50° field of view, field includes the optic disc and macula:
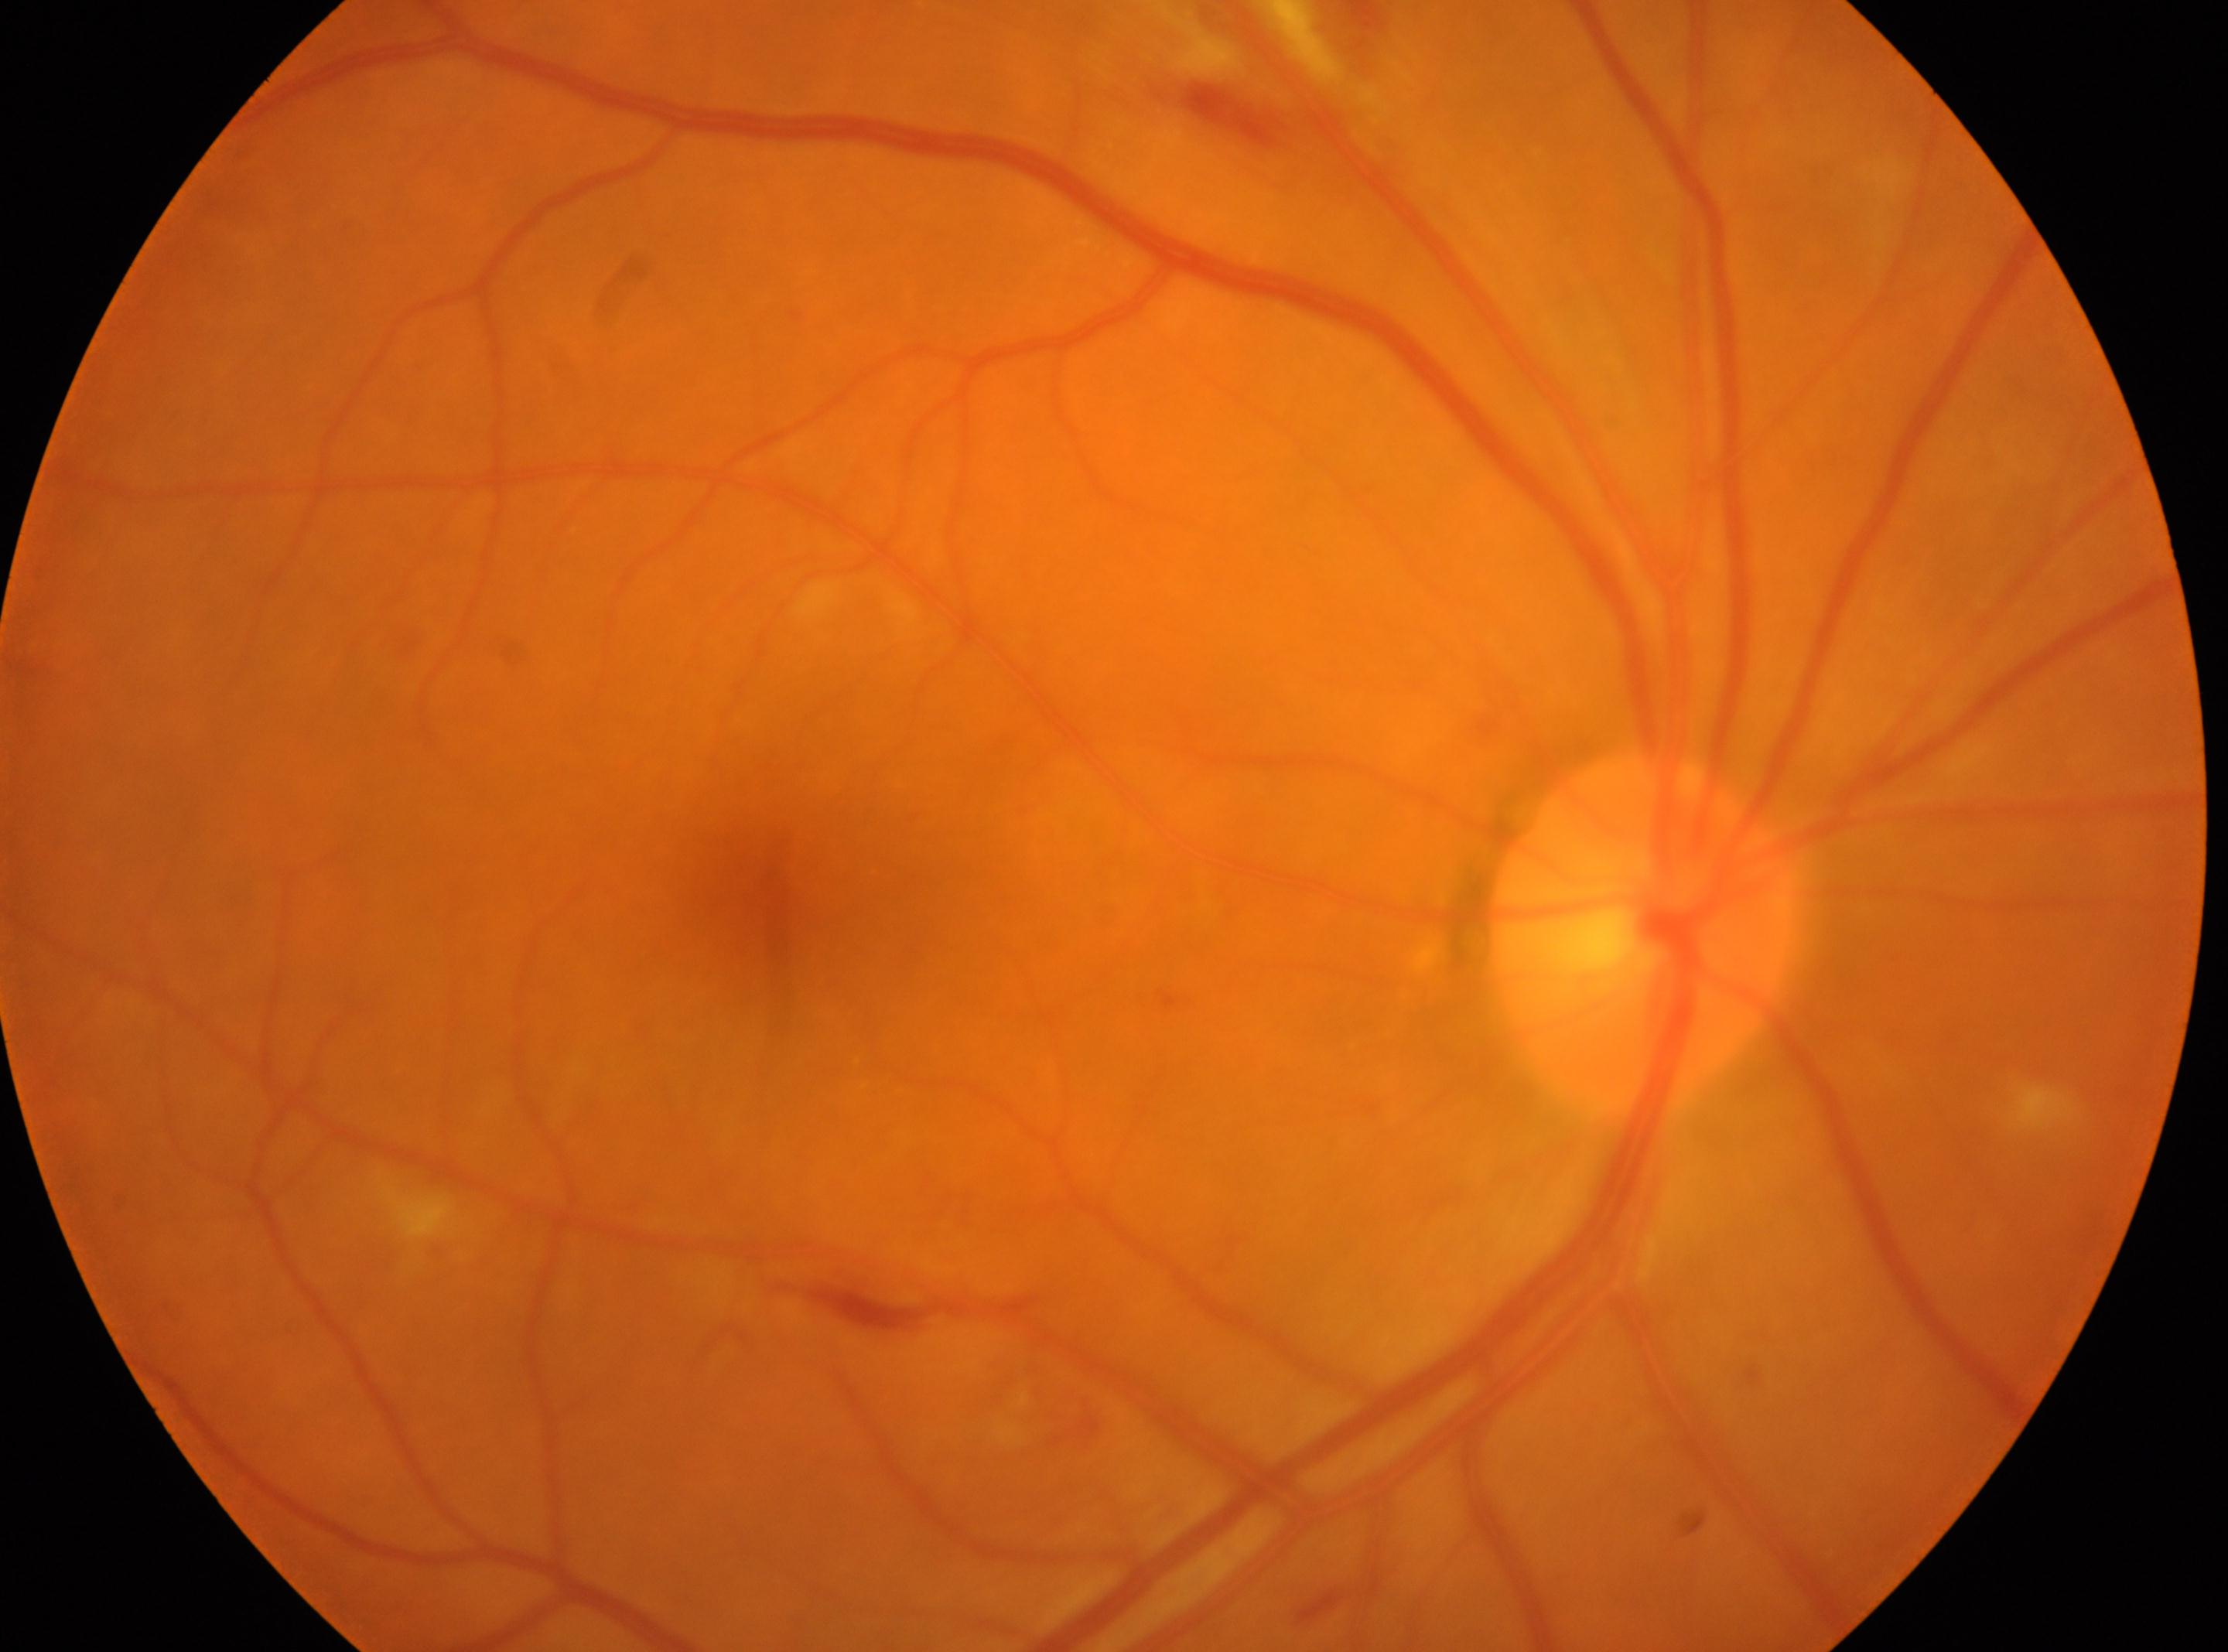 macula center=(x: 781, y: 883); diabetic retinopathy (DR)=moderate NPDR (grade 2); OD; non-proliferative diabetic retinopathy; optic disc=(x: 1640, y: 931).